45-degree field of view. CFP. 1932 by 1910 pixels:
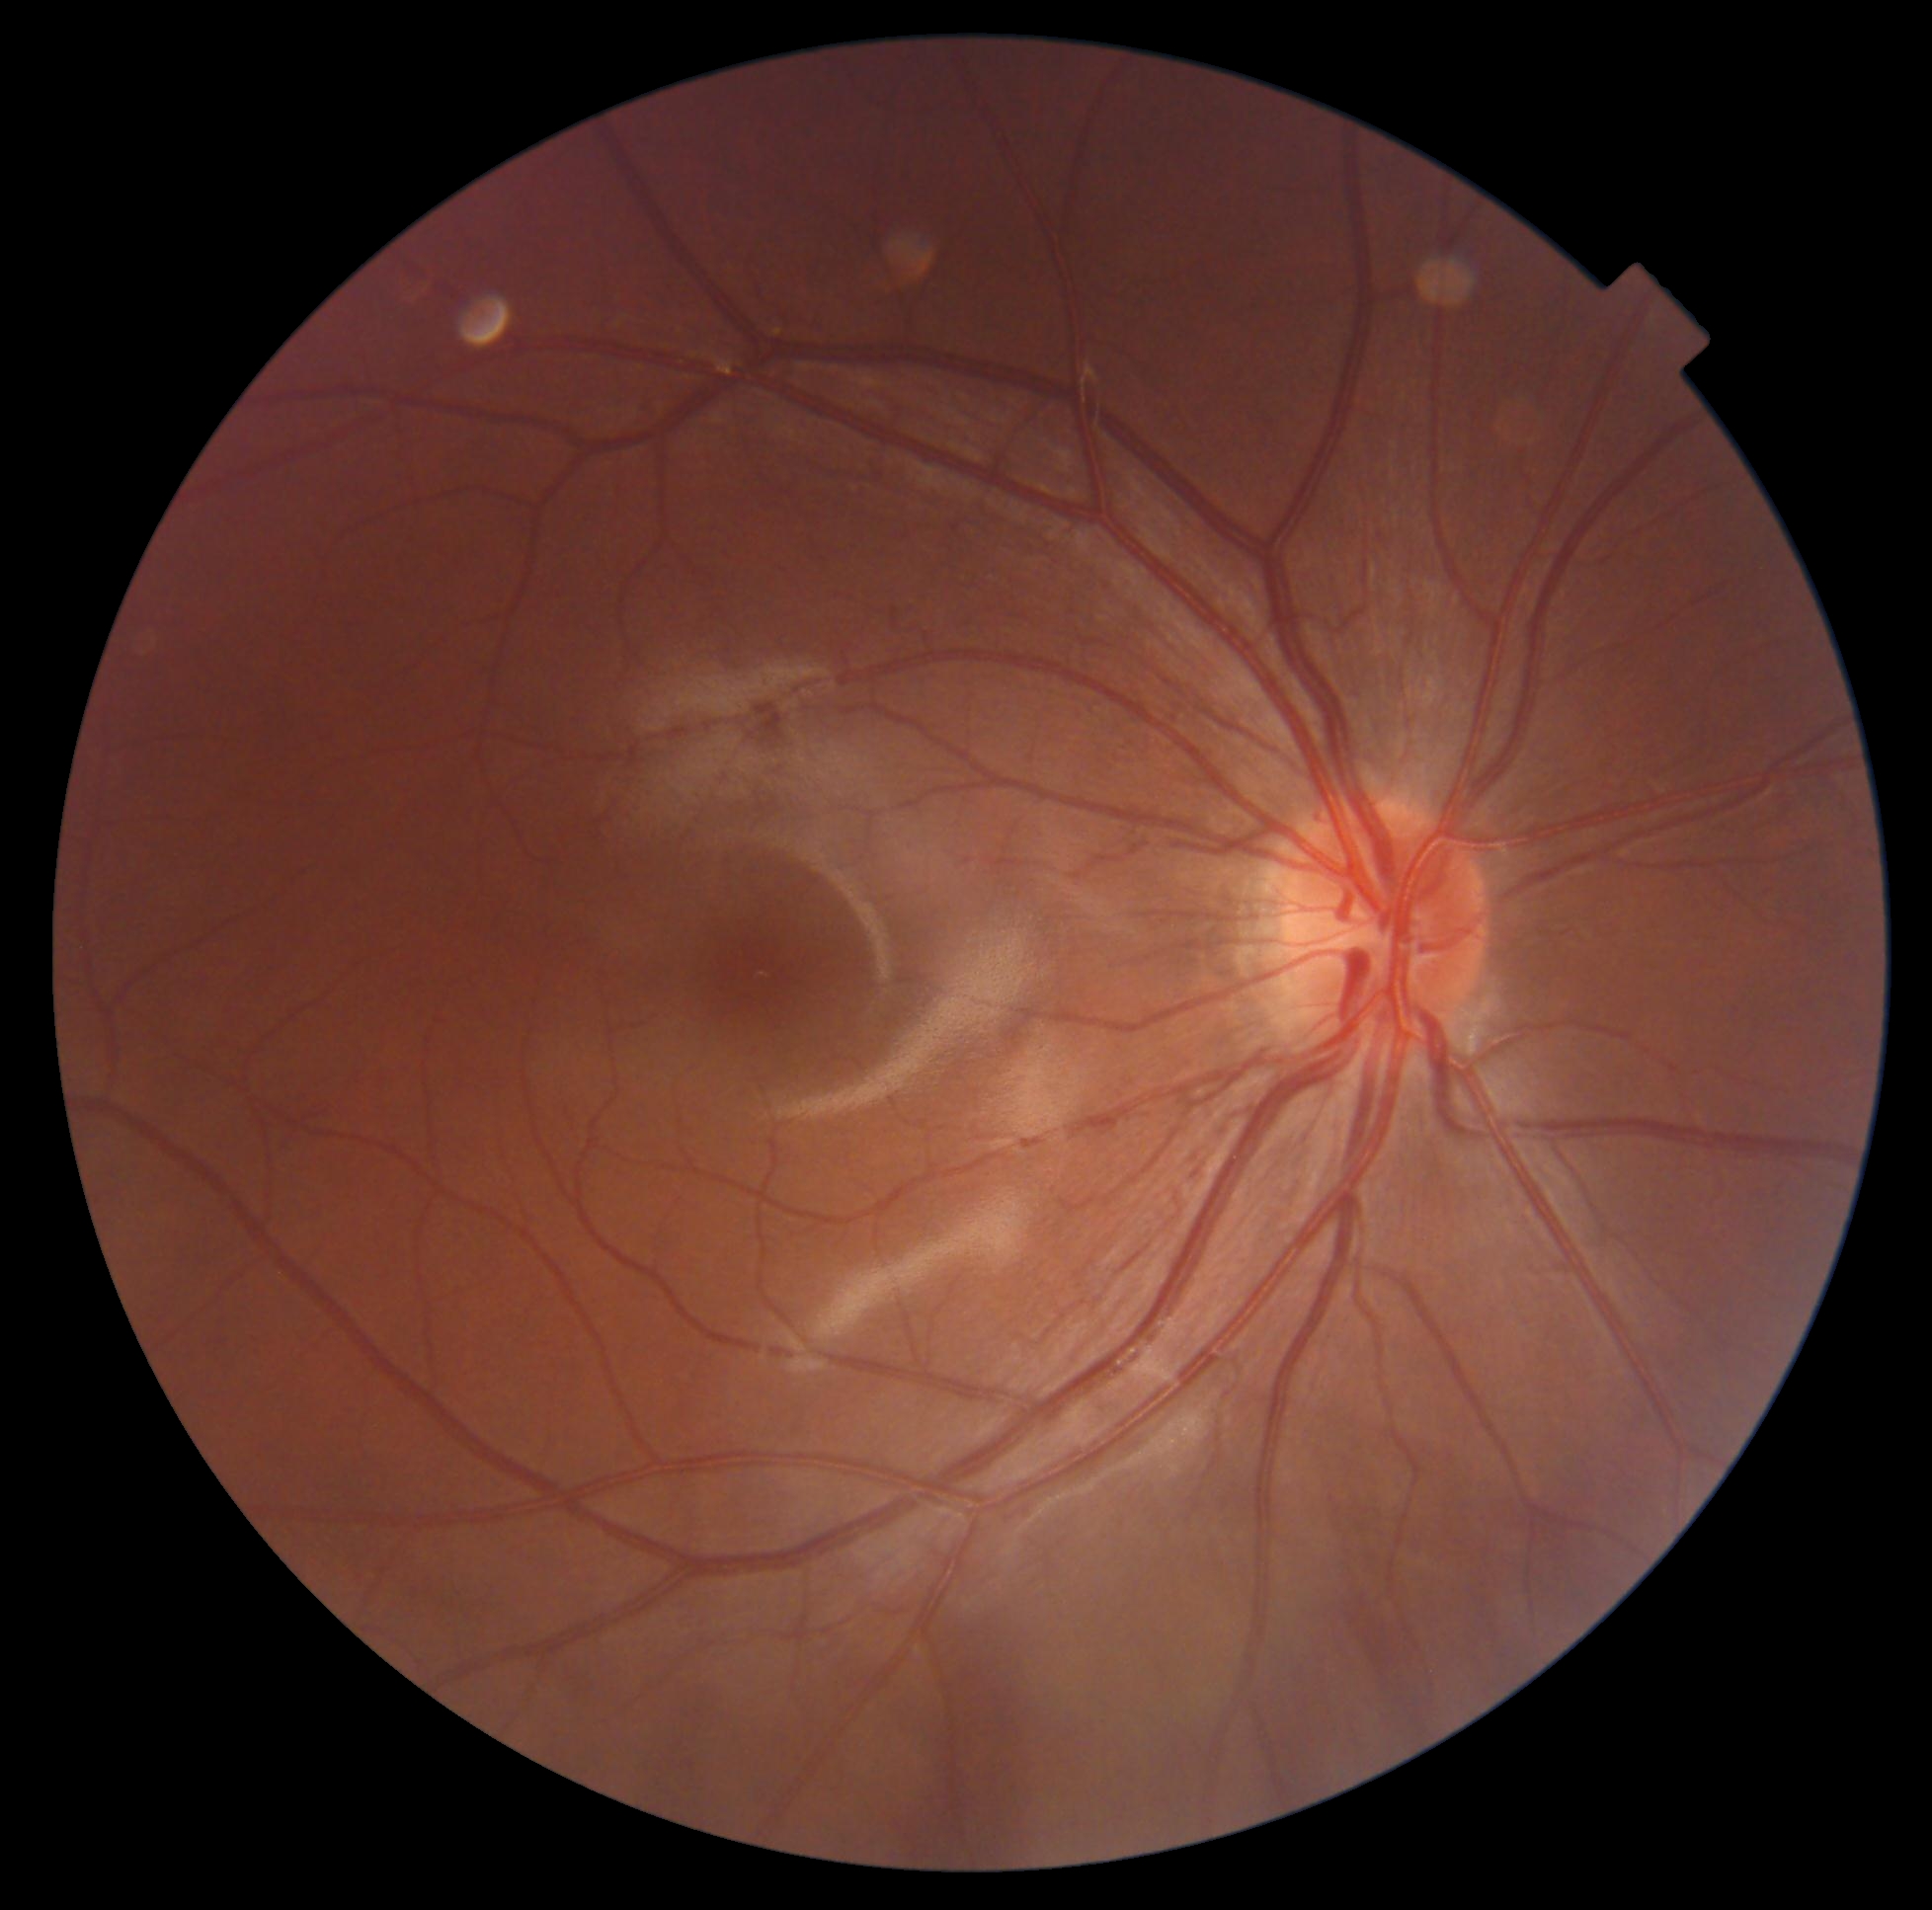
DR is grade 0 (no apparent retinopathy).